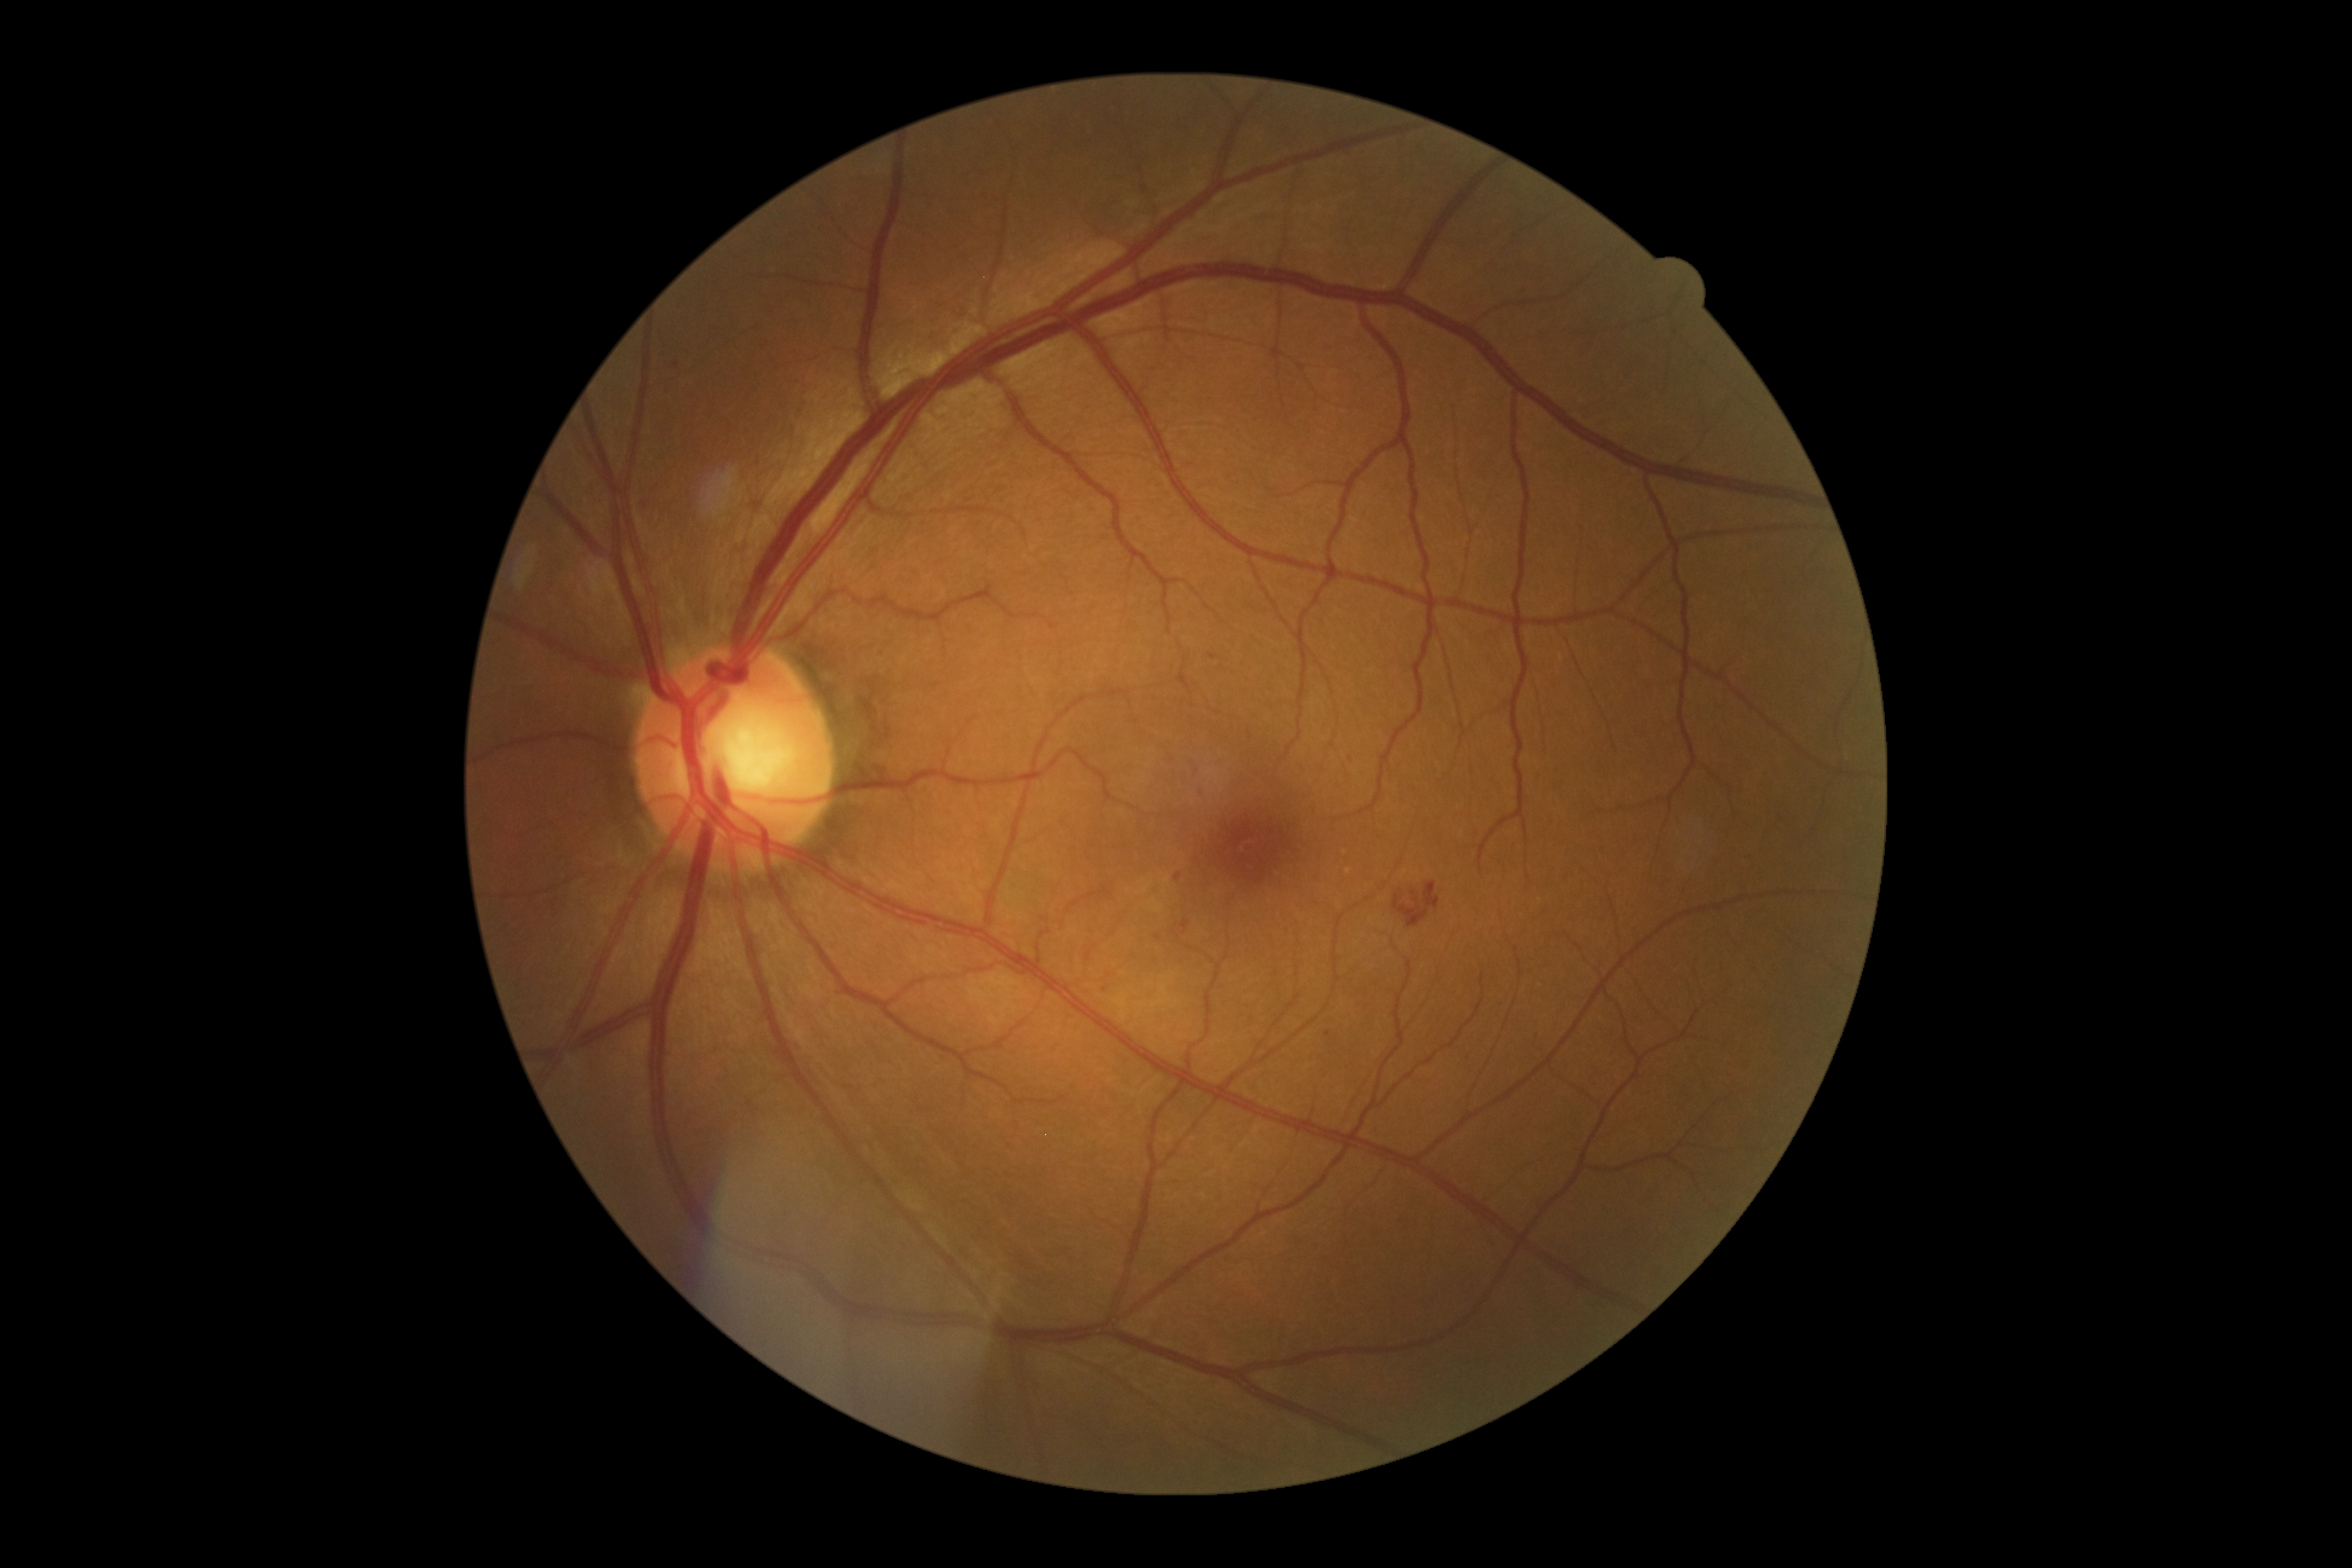 {"dr_grade": "2"}